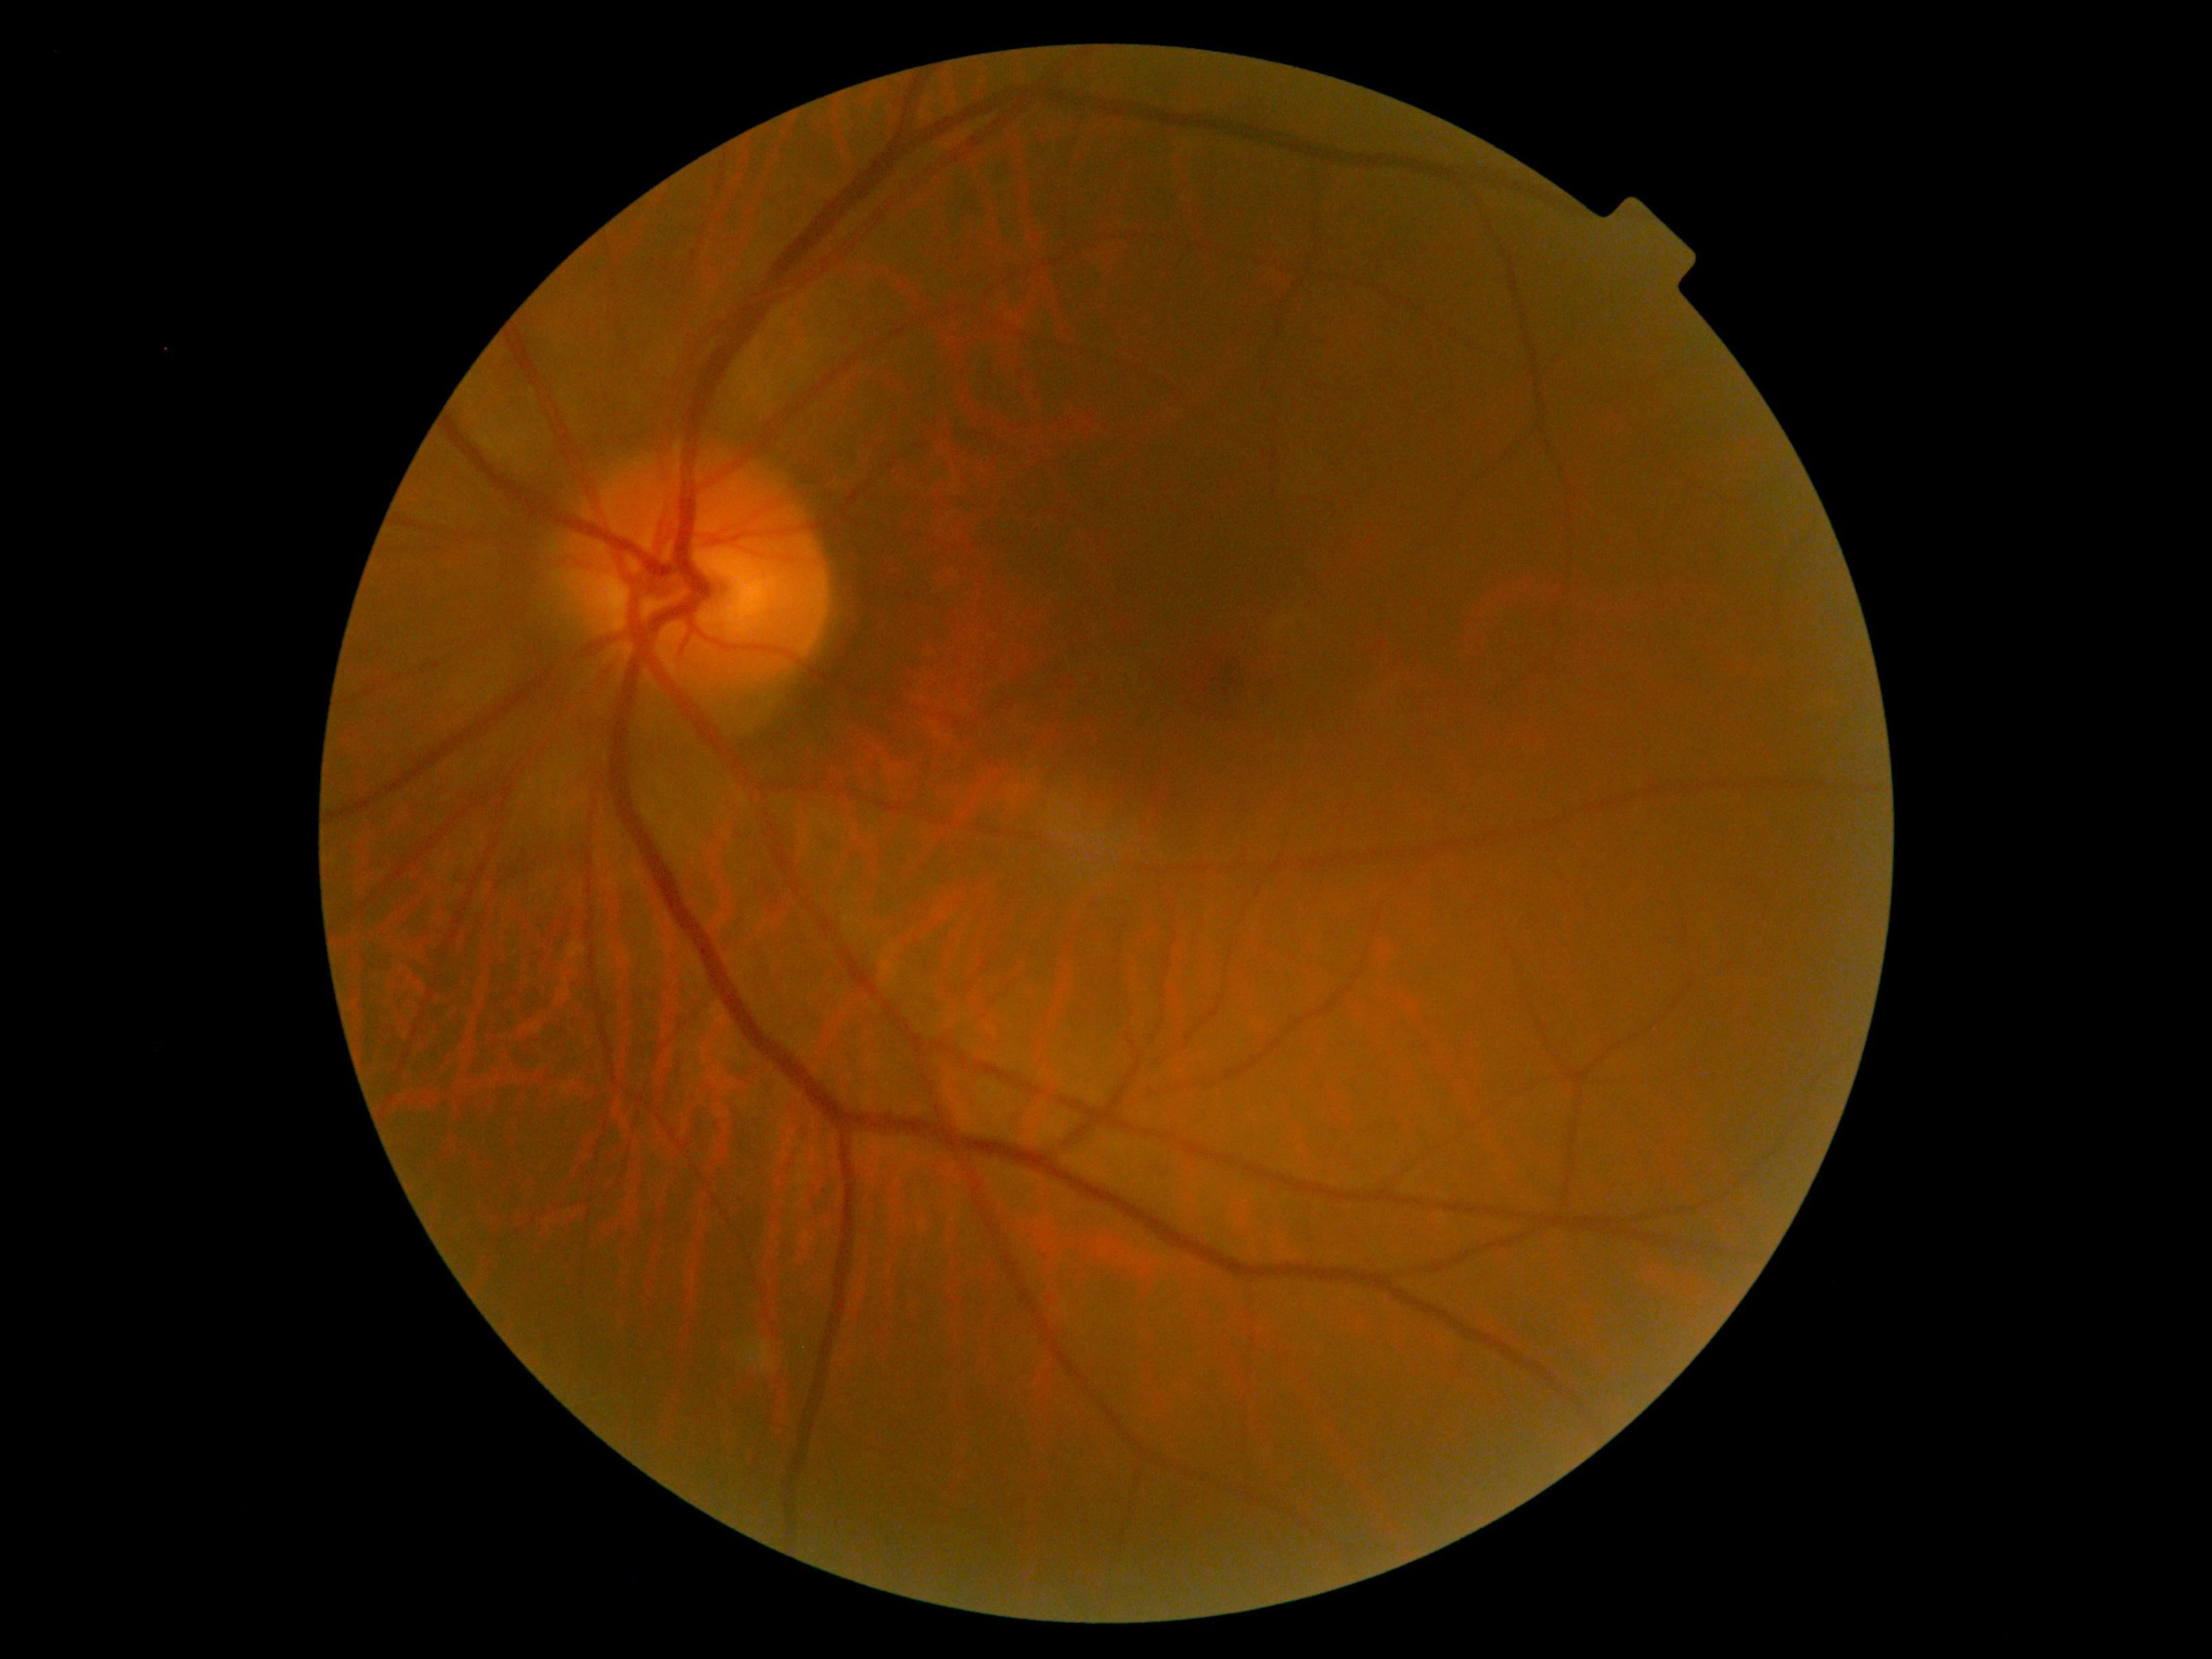
DR: no apparent retinopathy (grade 0) — no visible signs of diabetic retinopathy.